Color fundus photograph from a handheld portable camera: 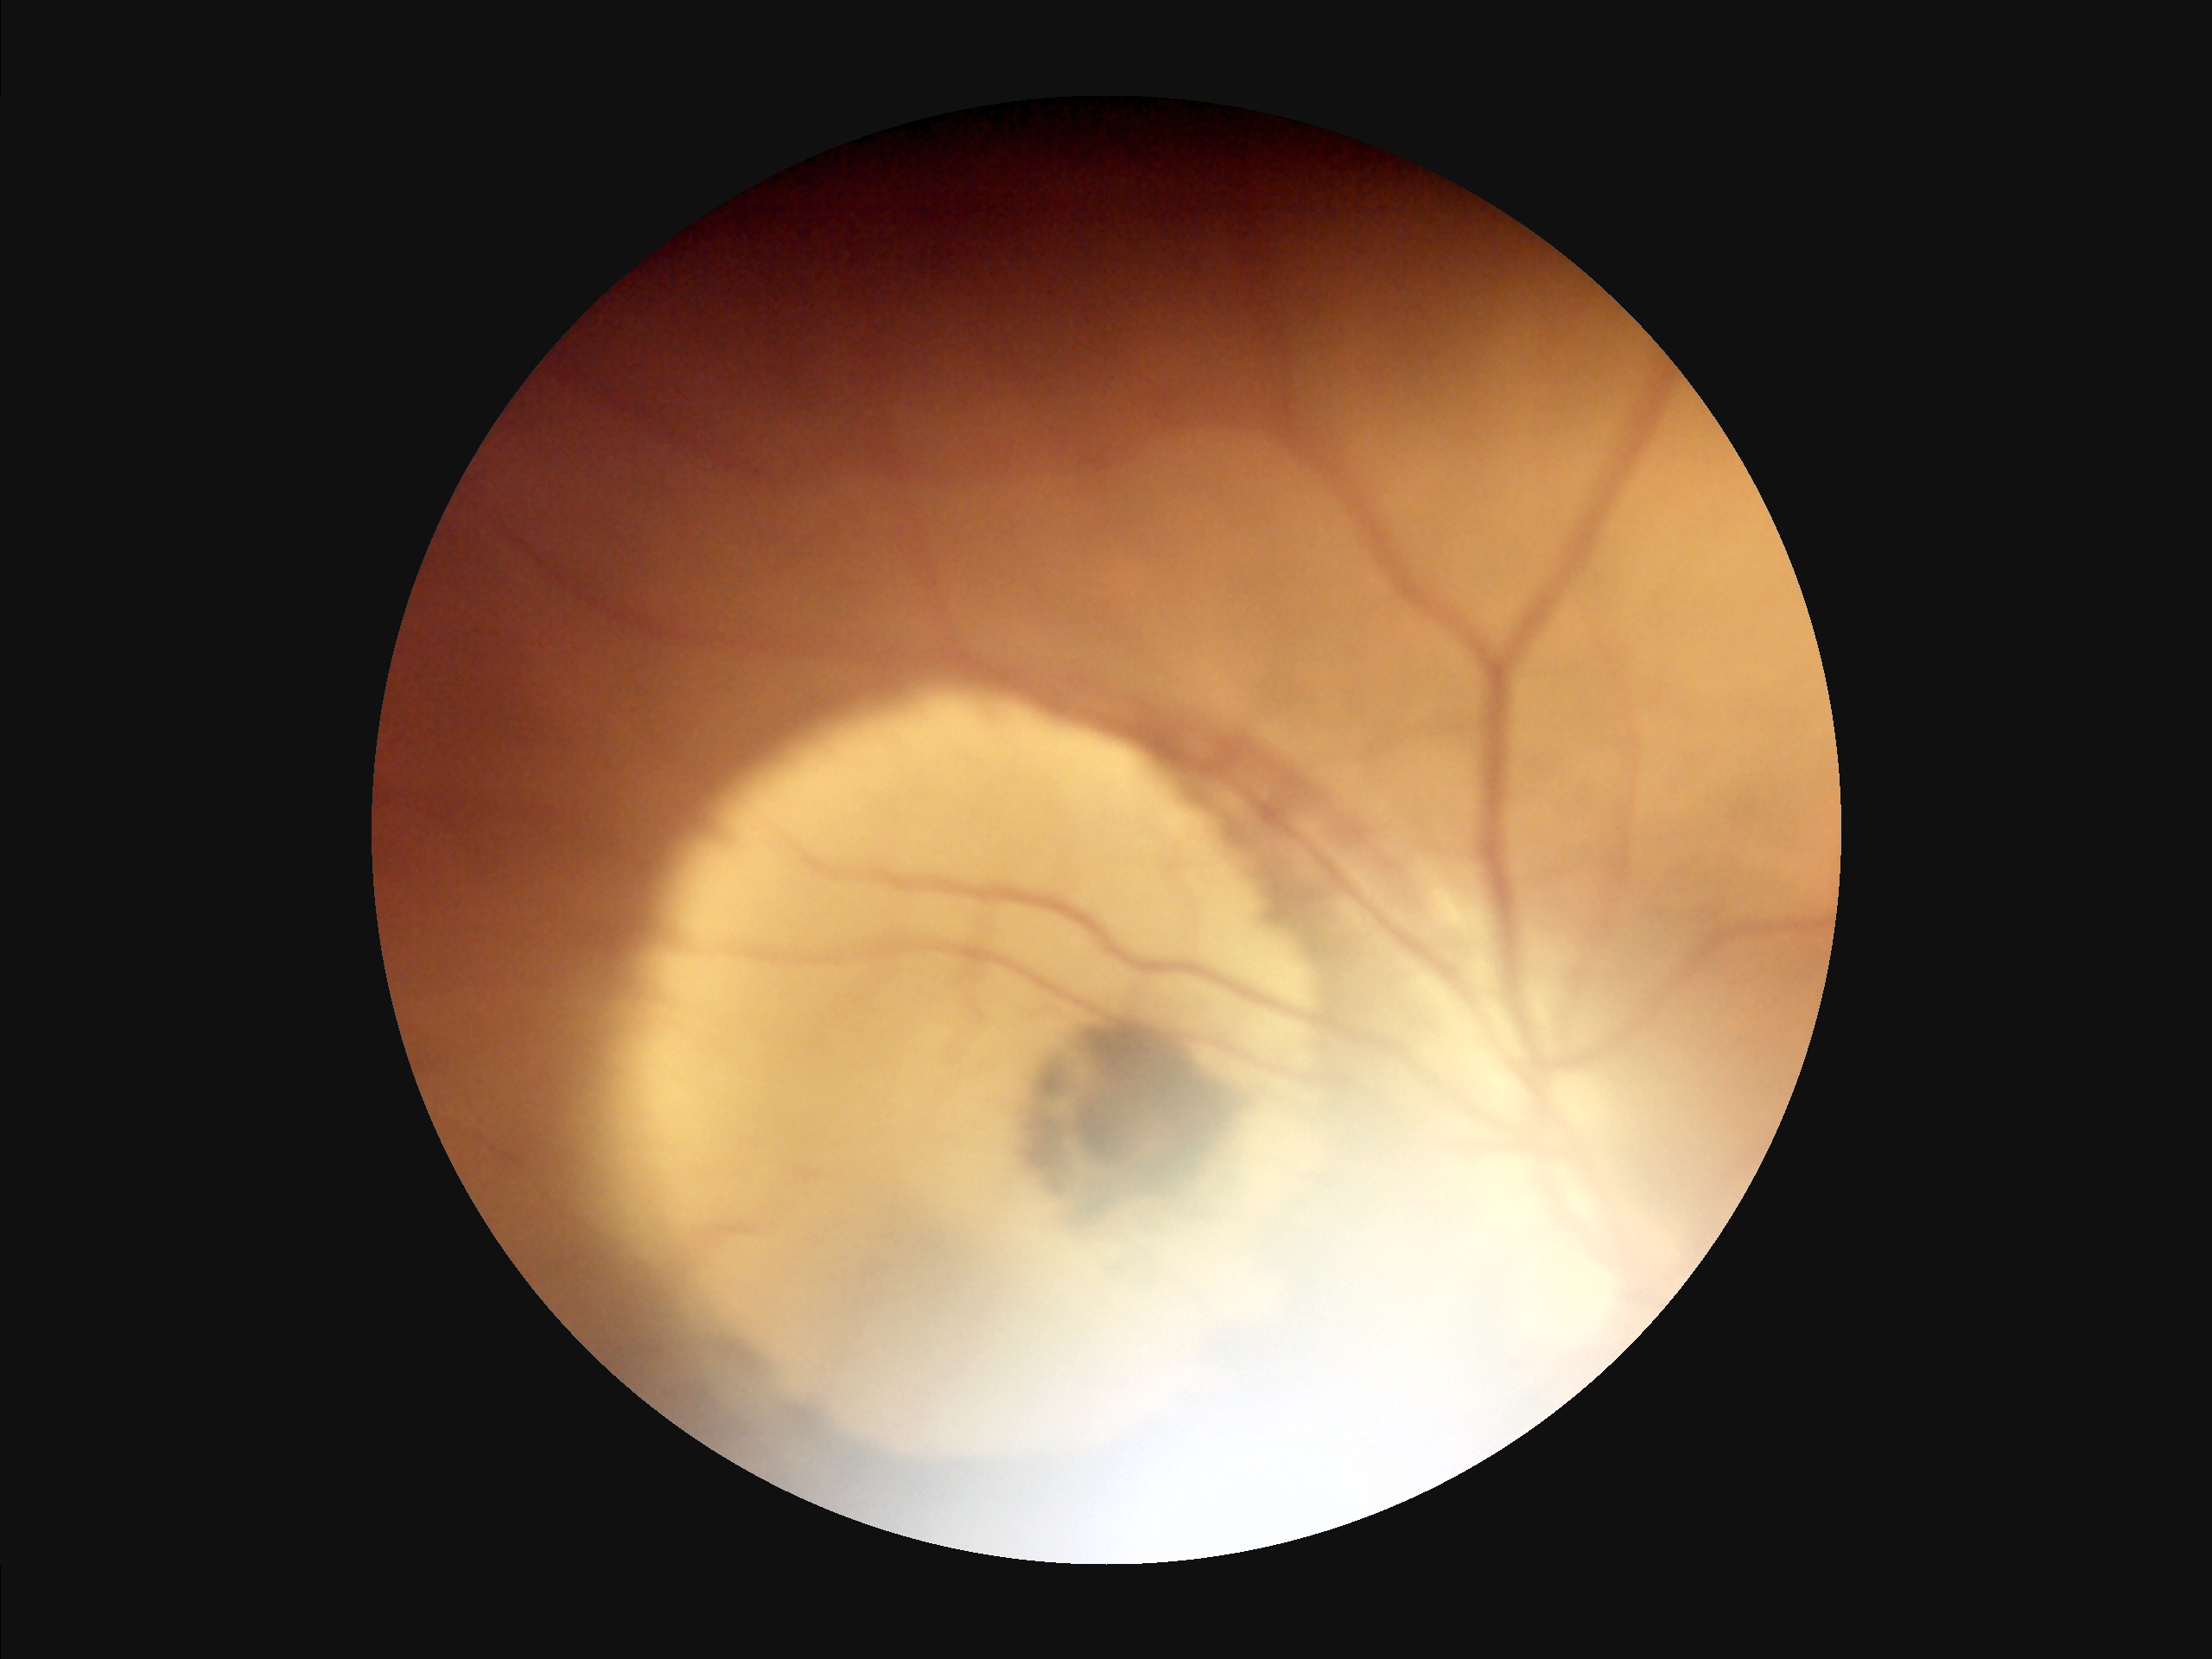 overall_quality: inadequate
contrast: poor
illumination: uneven
clarity: clear